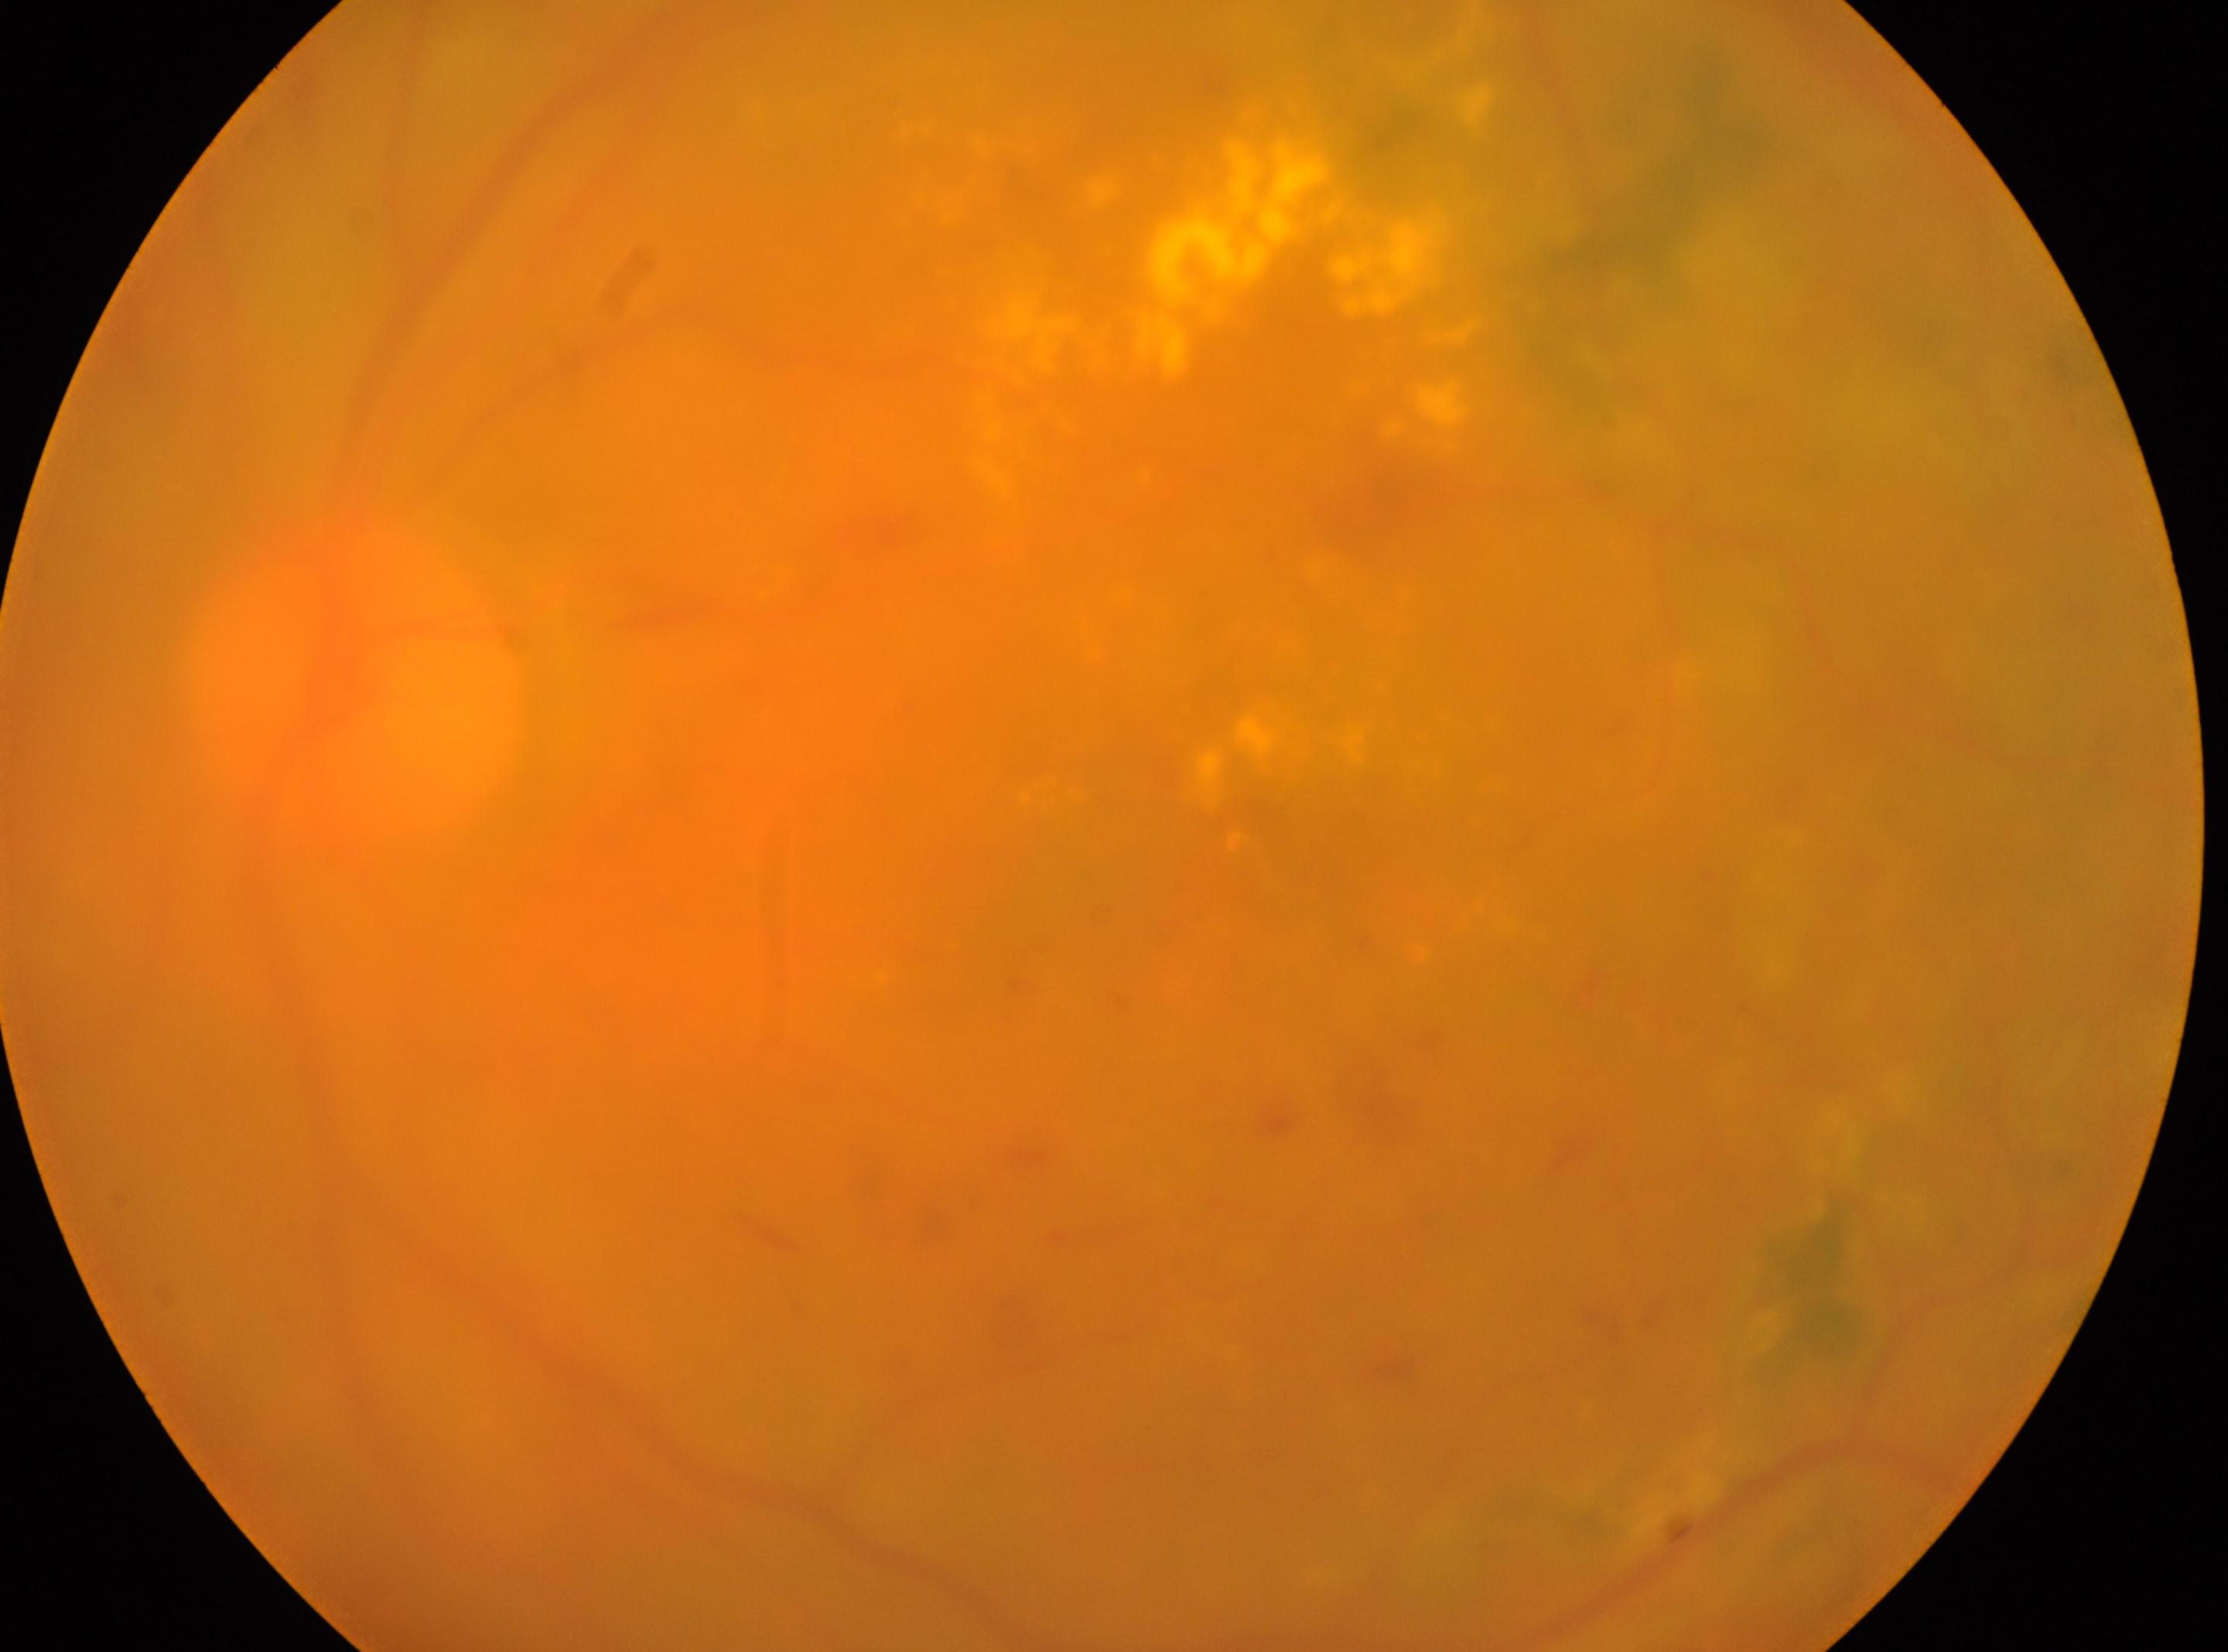 the fovea = 1120, 875
diabetic retinopathy (DR) = laser-treated DR, with underlying moderate non-proliferative diabetic retinopathy (grade 2)
eye = OS
disc center = 354, 683